RetCam wide-field infant fundus image; acquired on the Clarity RetCam 3; 640x480: 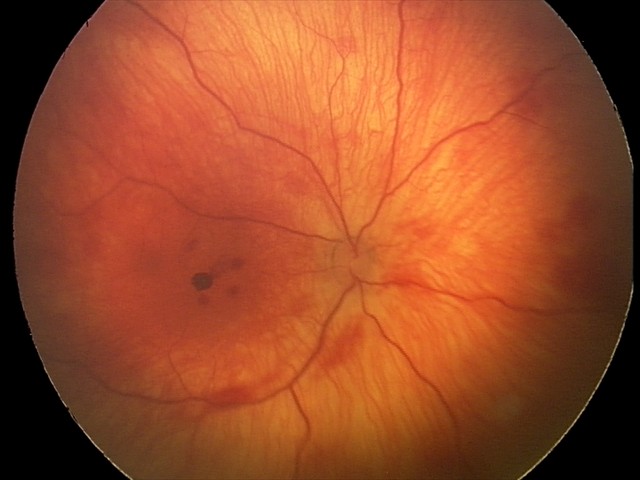

Q: What was the screening finding?
A: retinal hemorrhages